Modified Davis classification.
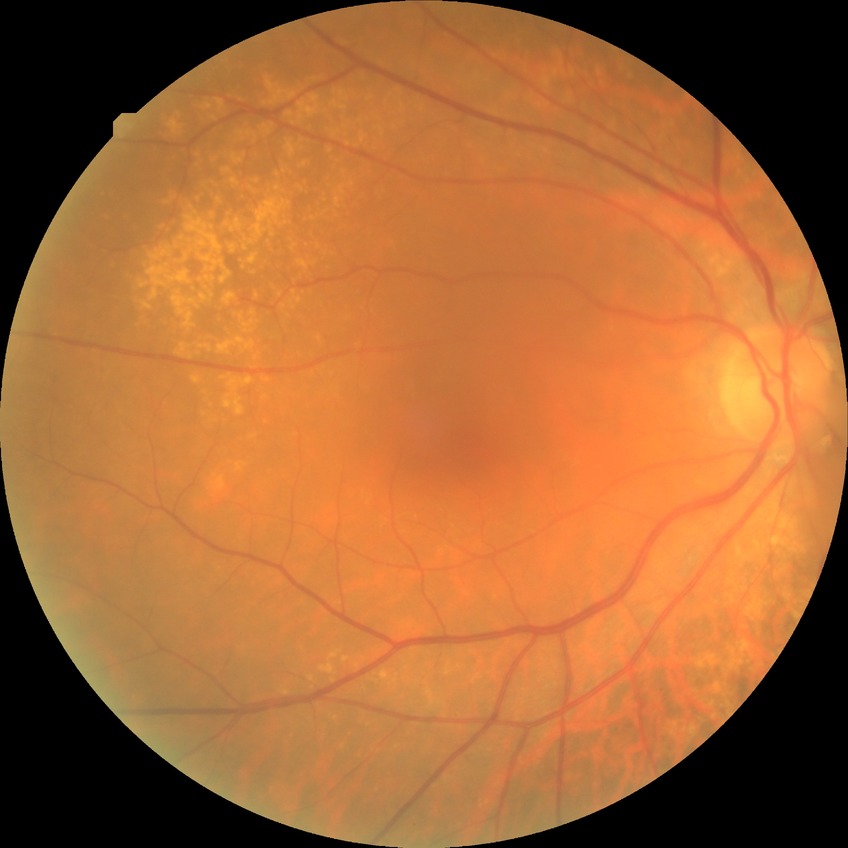 Diabetic retinopathy (DR) is NDR (no diabetic retinopathy).